Graded on the modified Davis scale.
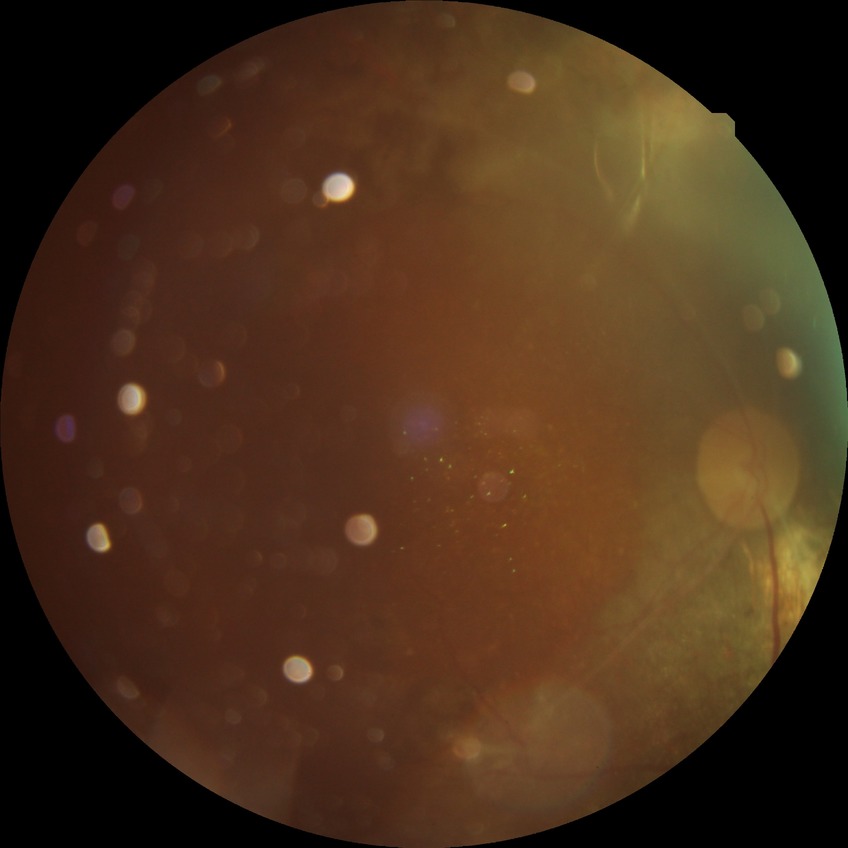

davis_grade: PDR (proliferative diabetic retinopathy)